Diabetic retinopathy graded by the modified Davis classification.
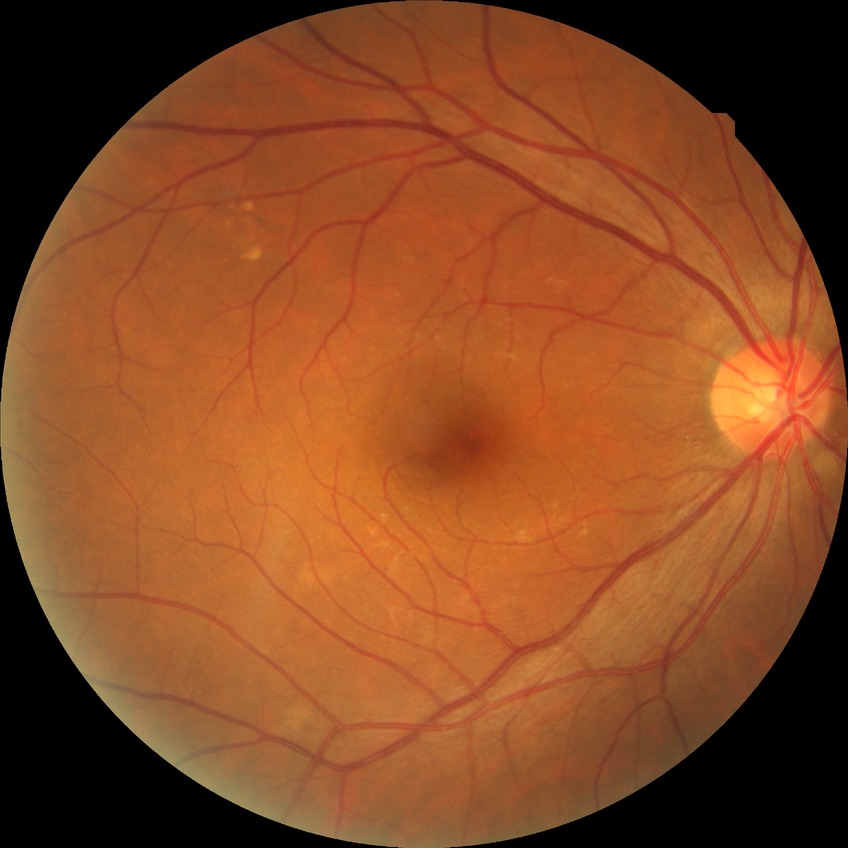   dr_impression: negative for DR
  davis_grade: NDR